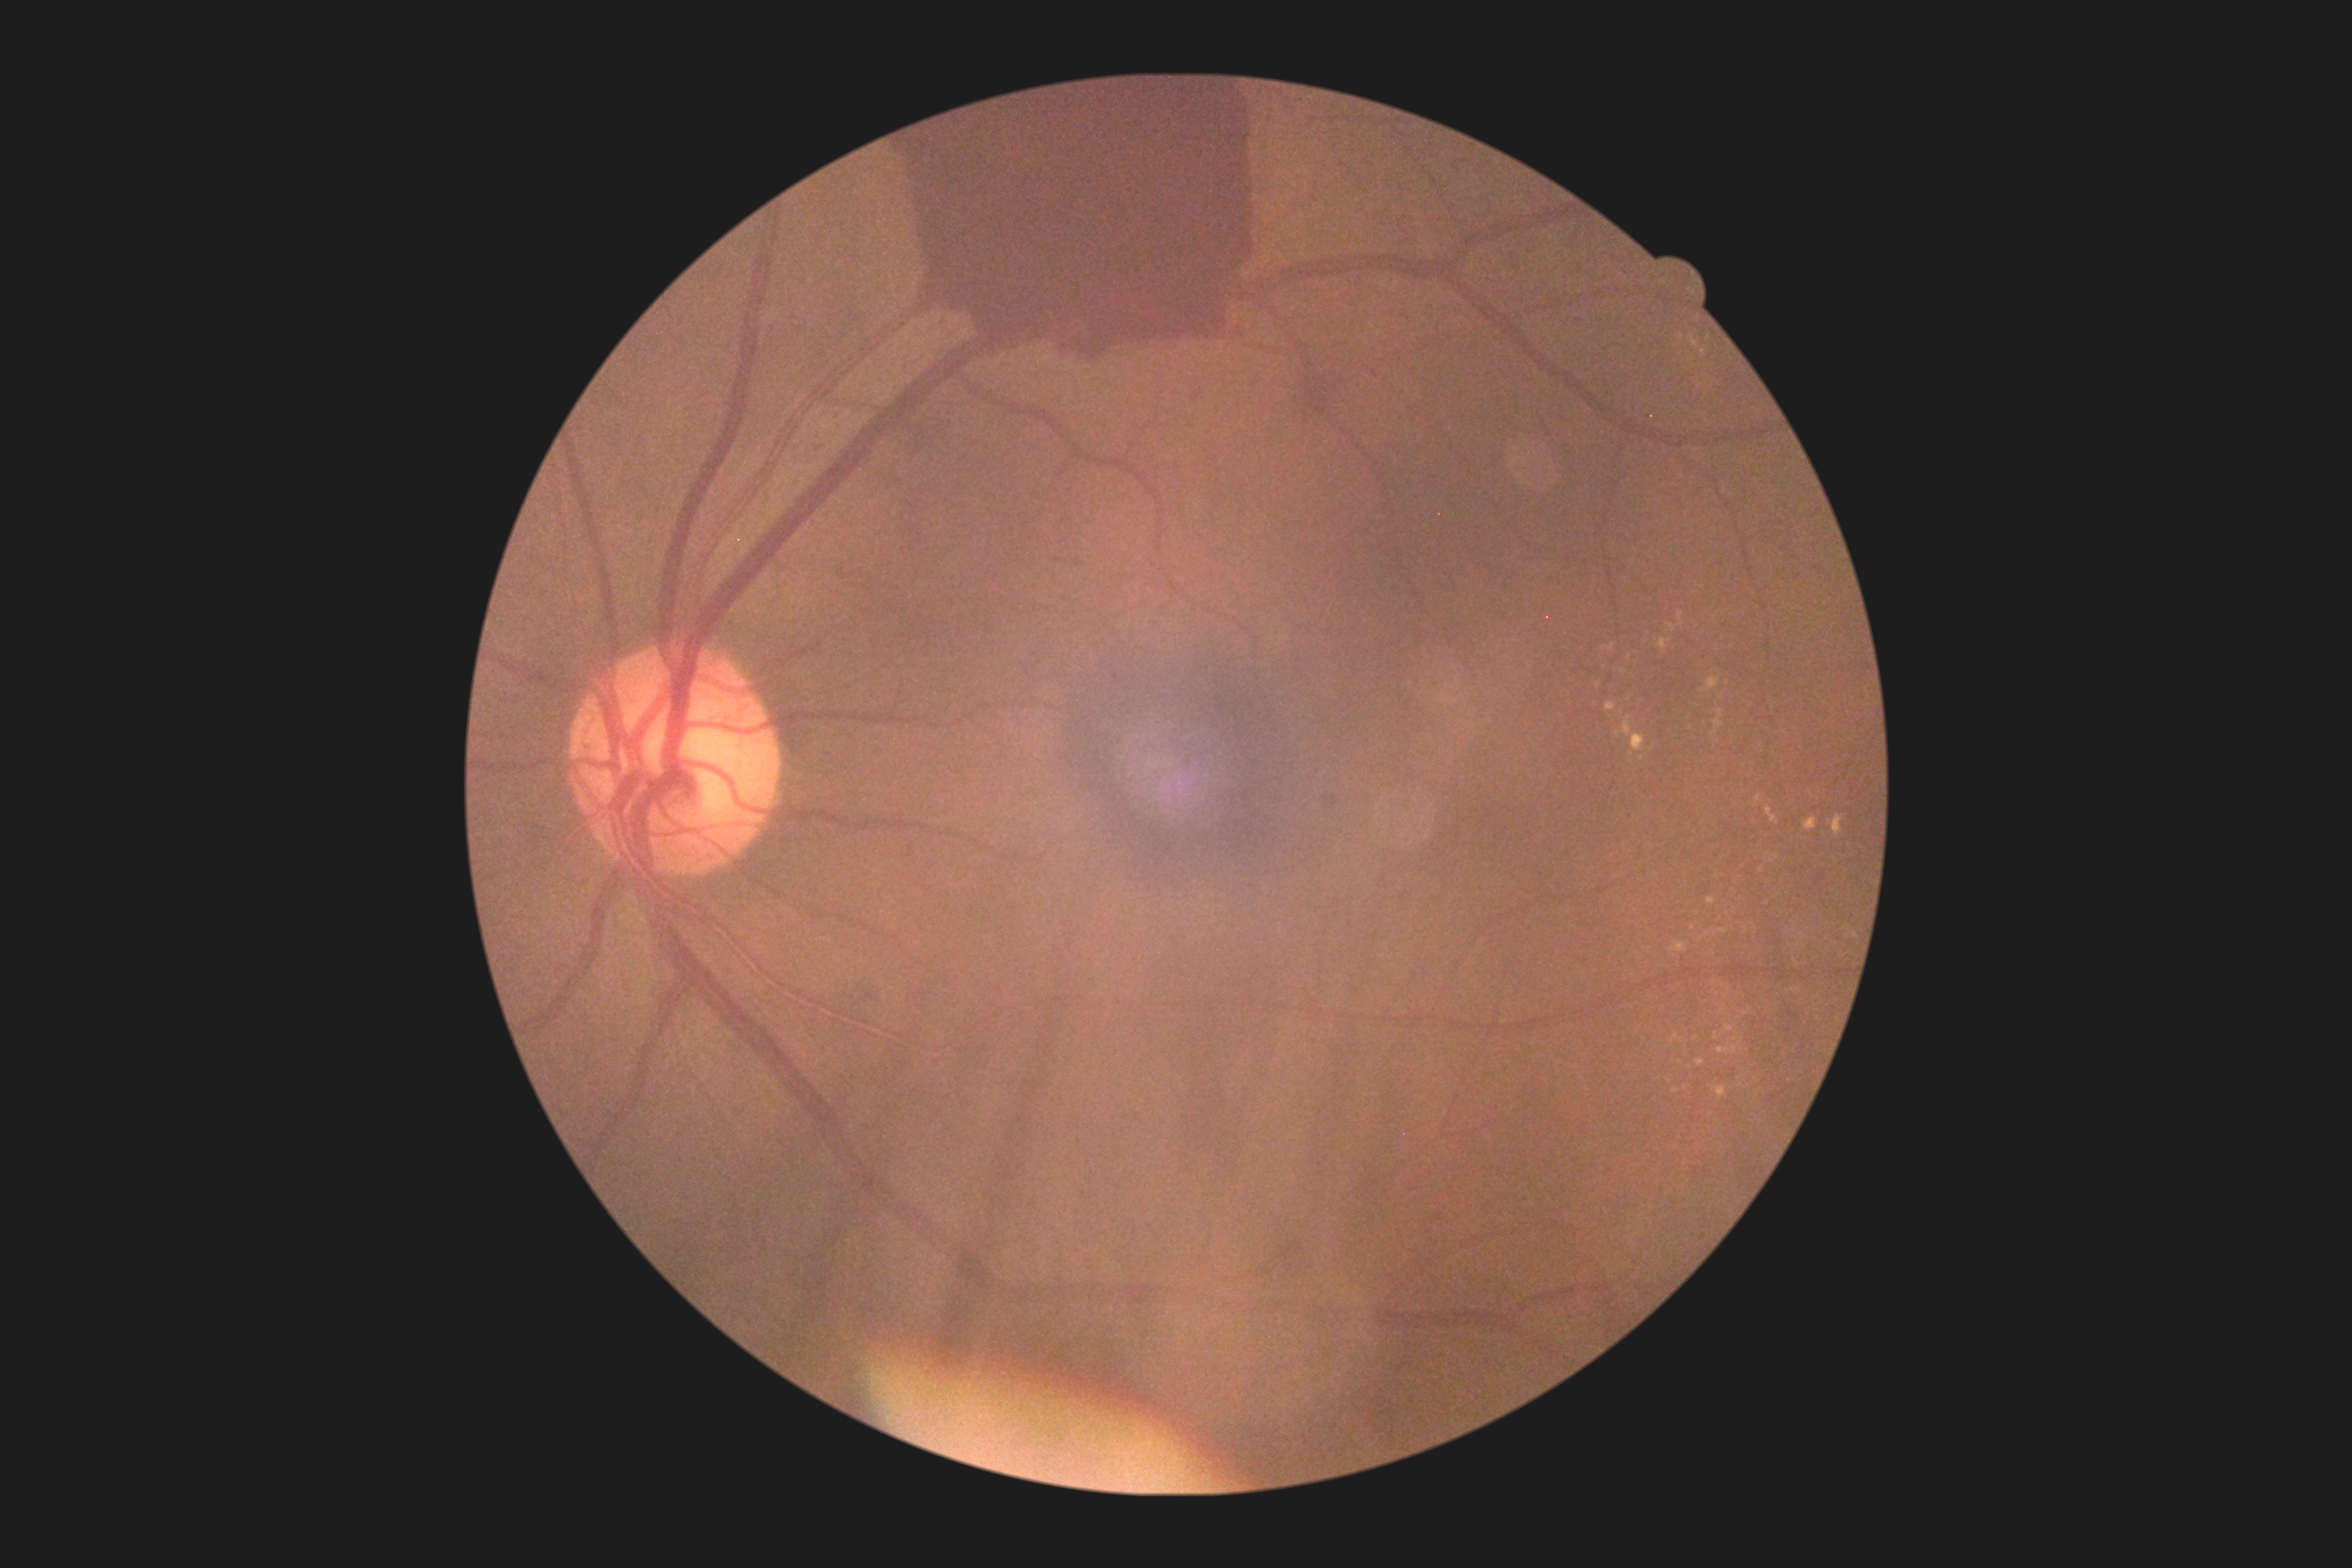
DR stage: 4.